Camera: Topcon TRC-50DX: 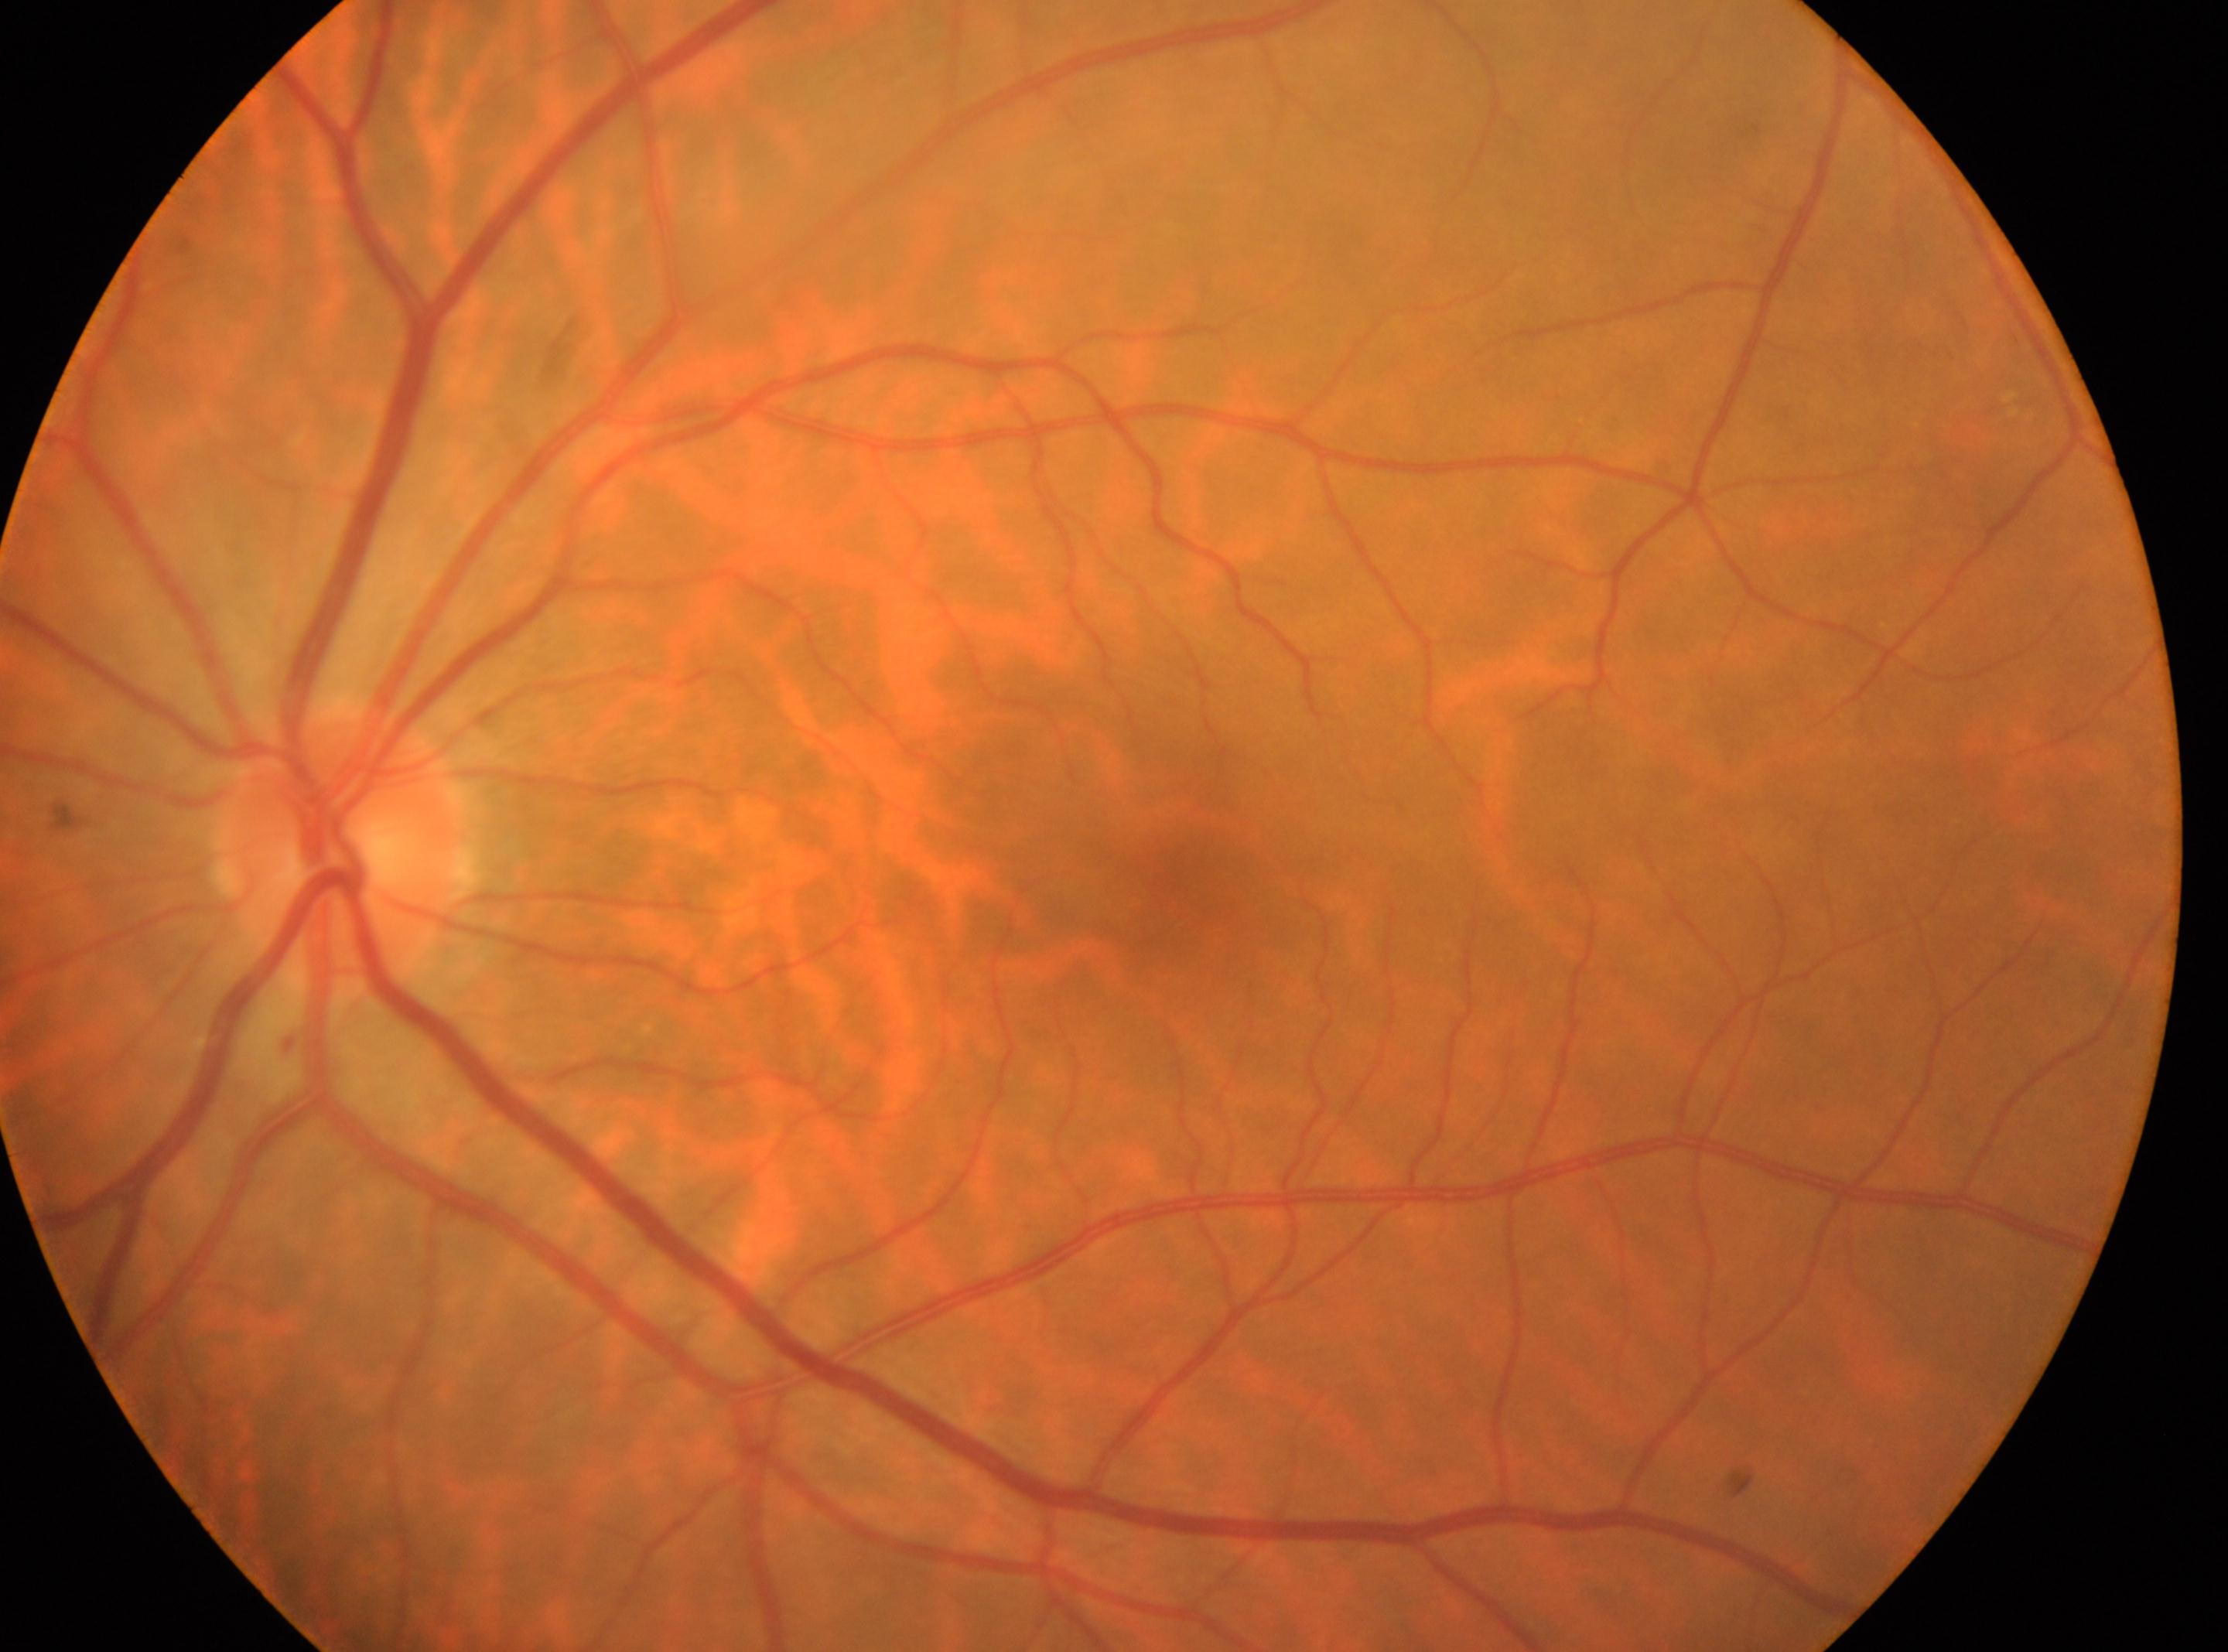
This is the left eye. DR stage: no apparent retinopathy (grade 0). Optic disk: 337px, 850px. The macular center is at 1173px, 902px.